Pediatric retinal photograph (wide-field)
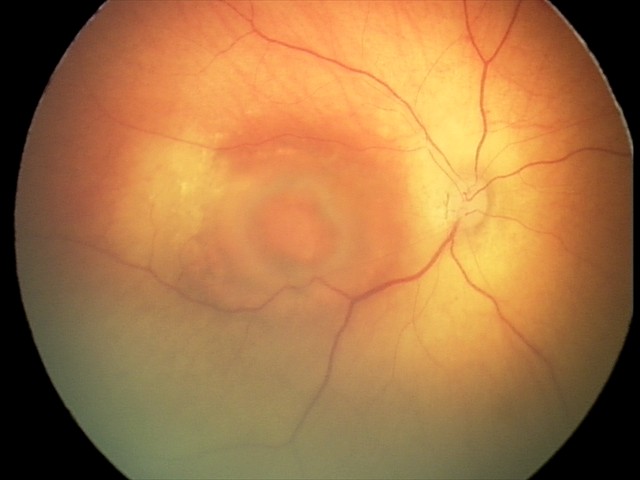
Assessment: toxoplasmosis chorioretinitis.